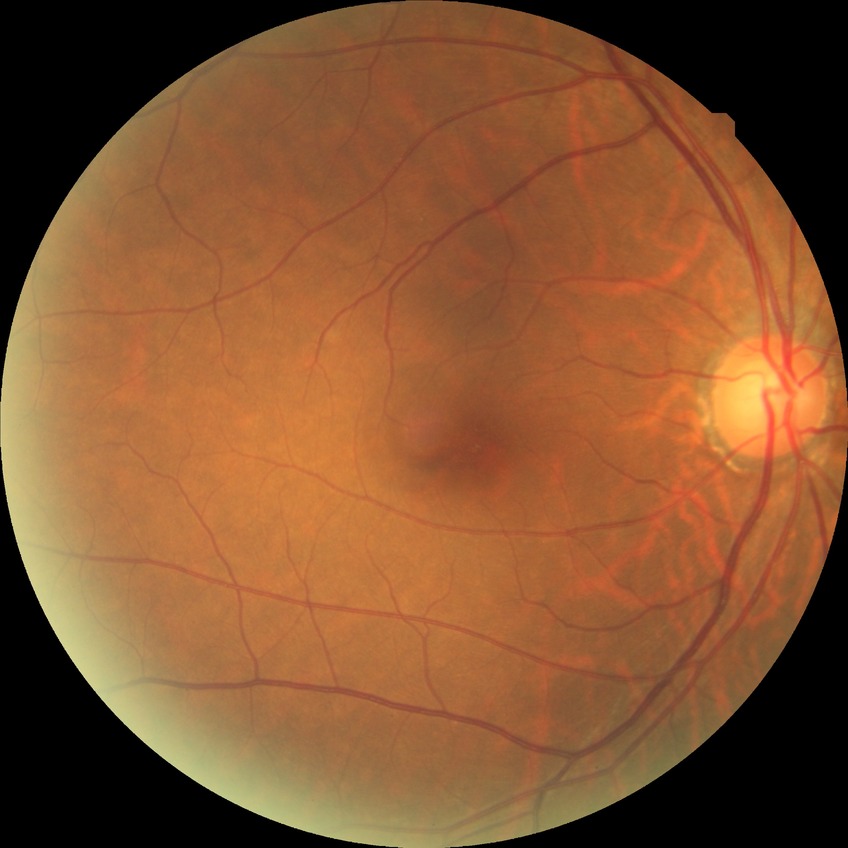

Findings:
* diabetic retinopathy severity — no diabetic retinopathy